Axial length 22.68 mm. Female patient. Retinal fundus photograph. Patient age: 67 years. IOP by non-contact tonometry: 9 mmHg. Pachymetry: 482 µm. 30-degree field of view: 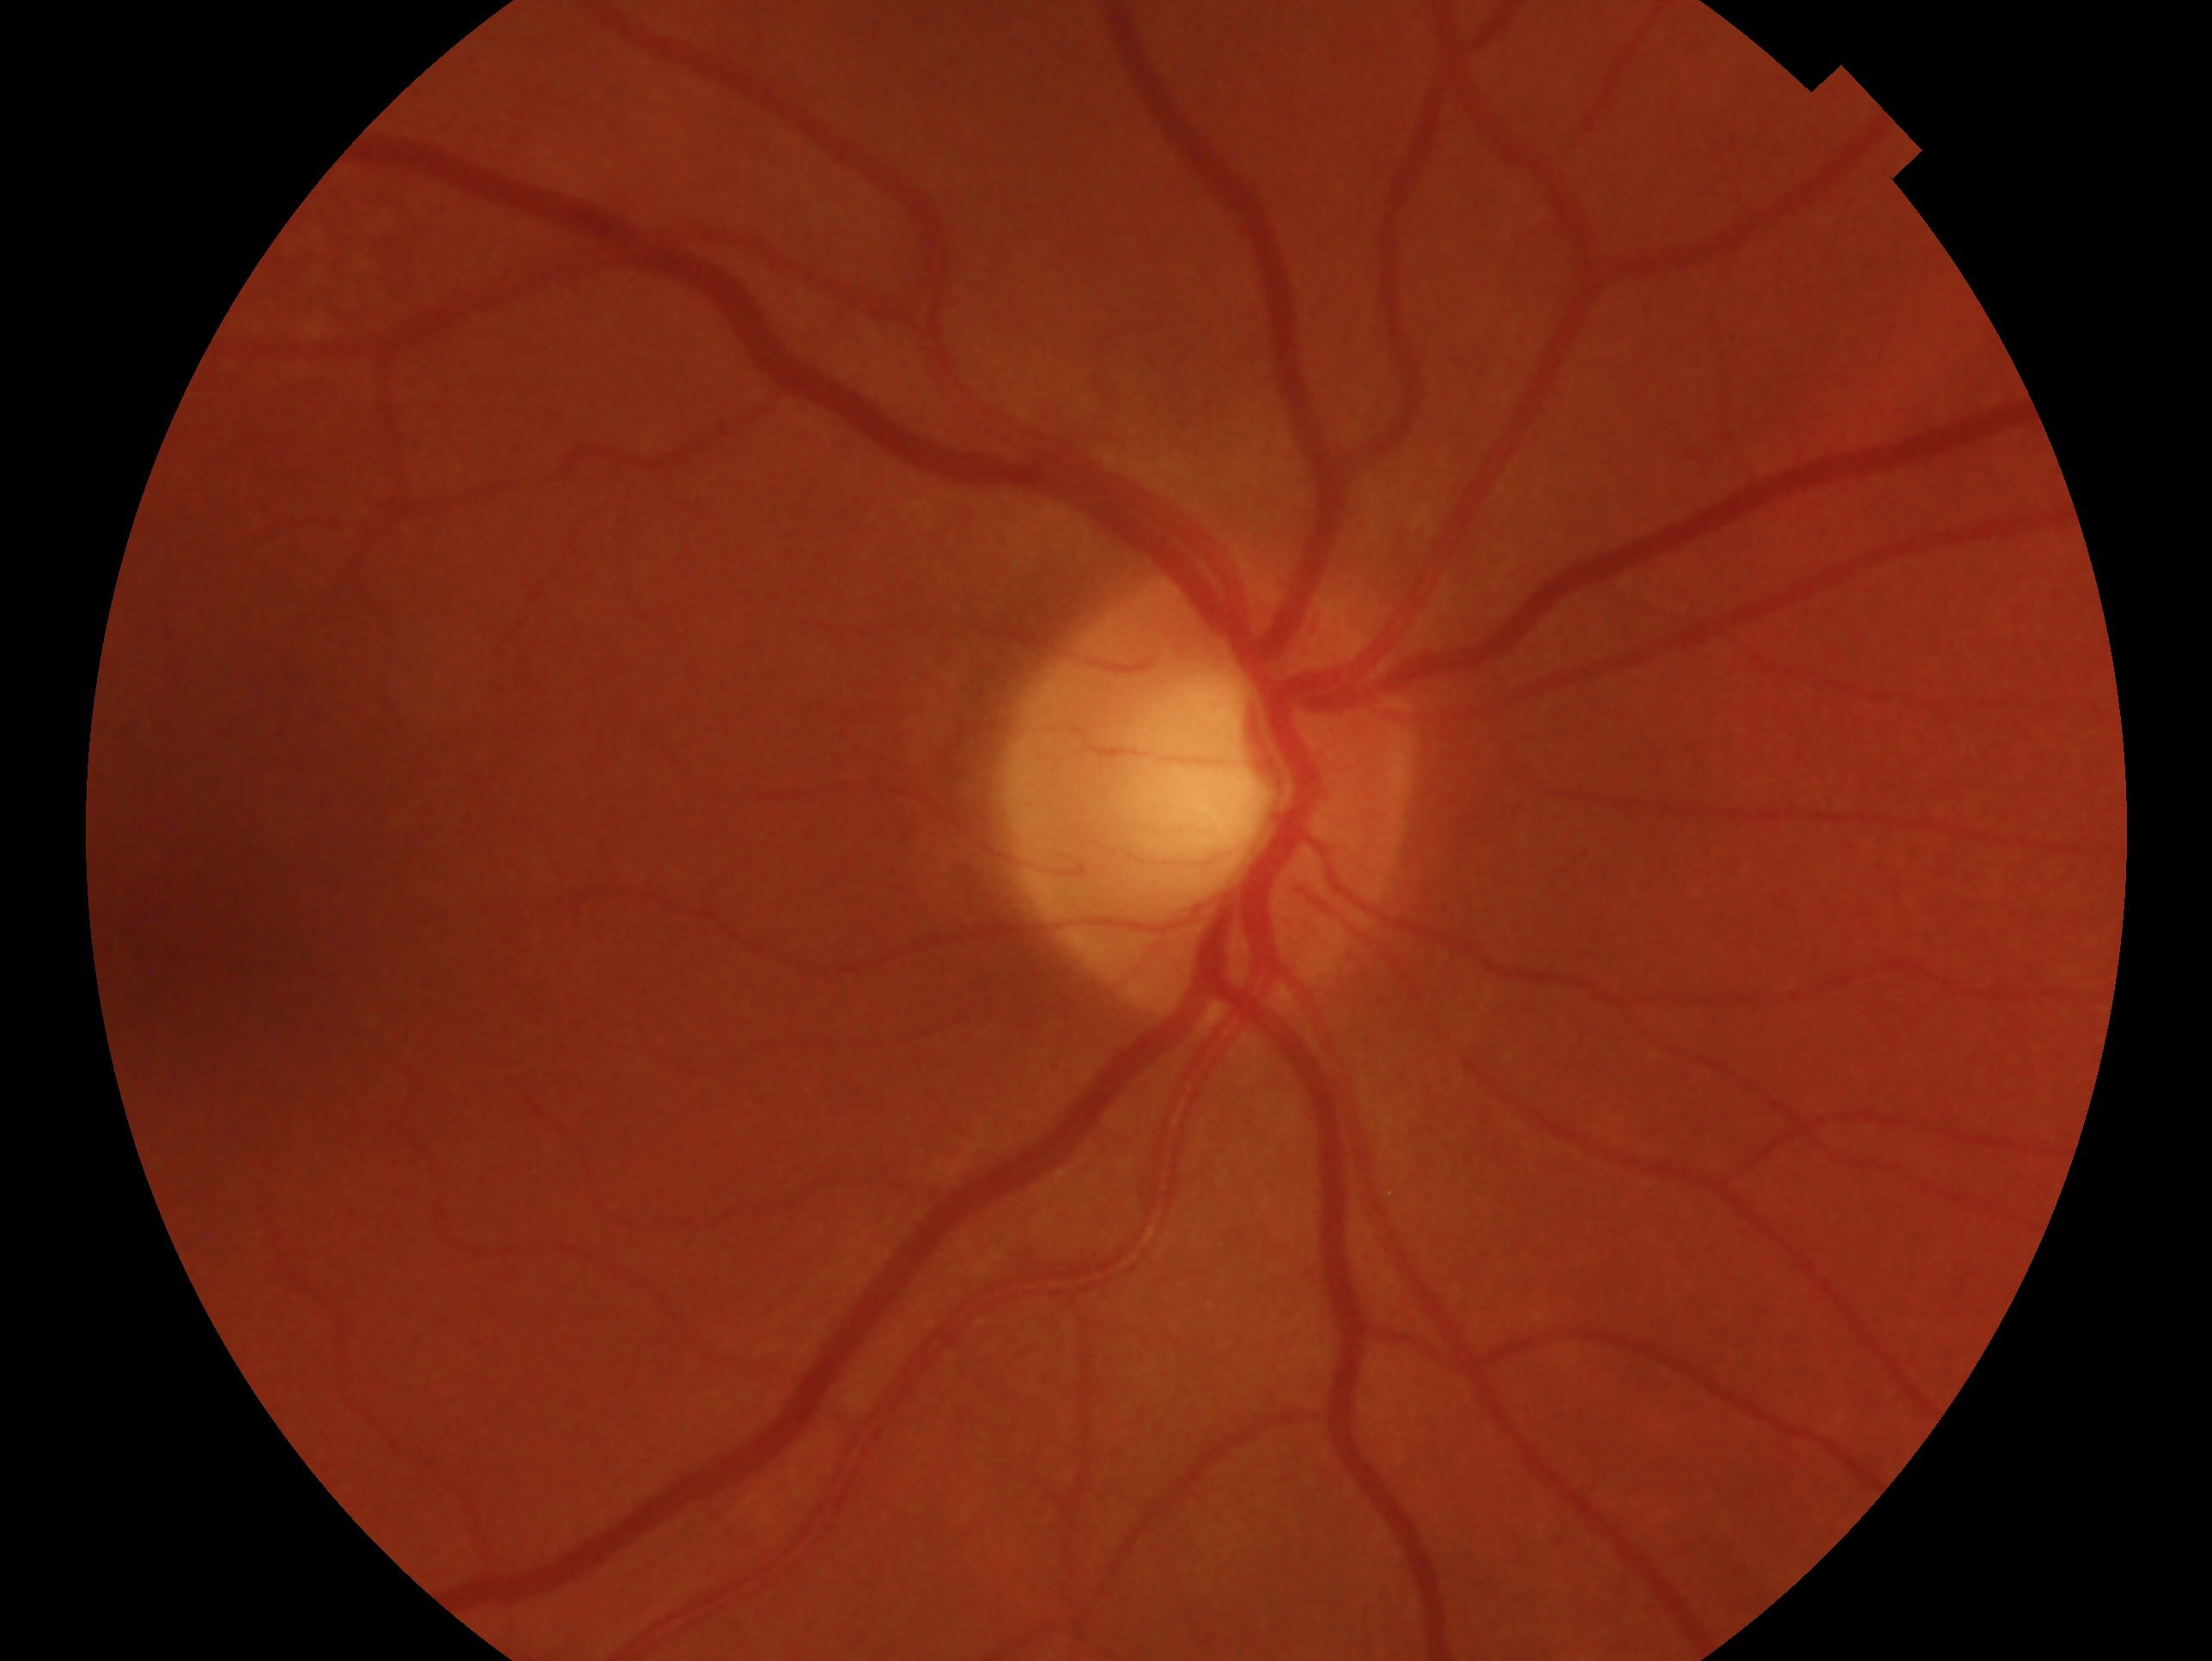
- glaucoma diagnosis: no glaucomatous findings
- laterality: right